Fundus photo:
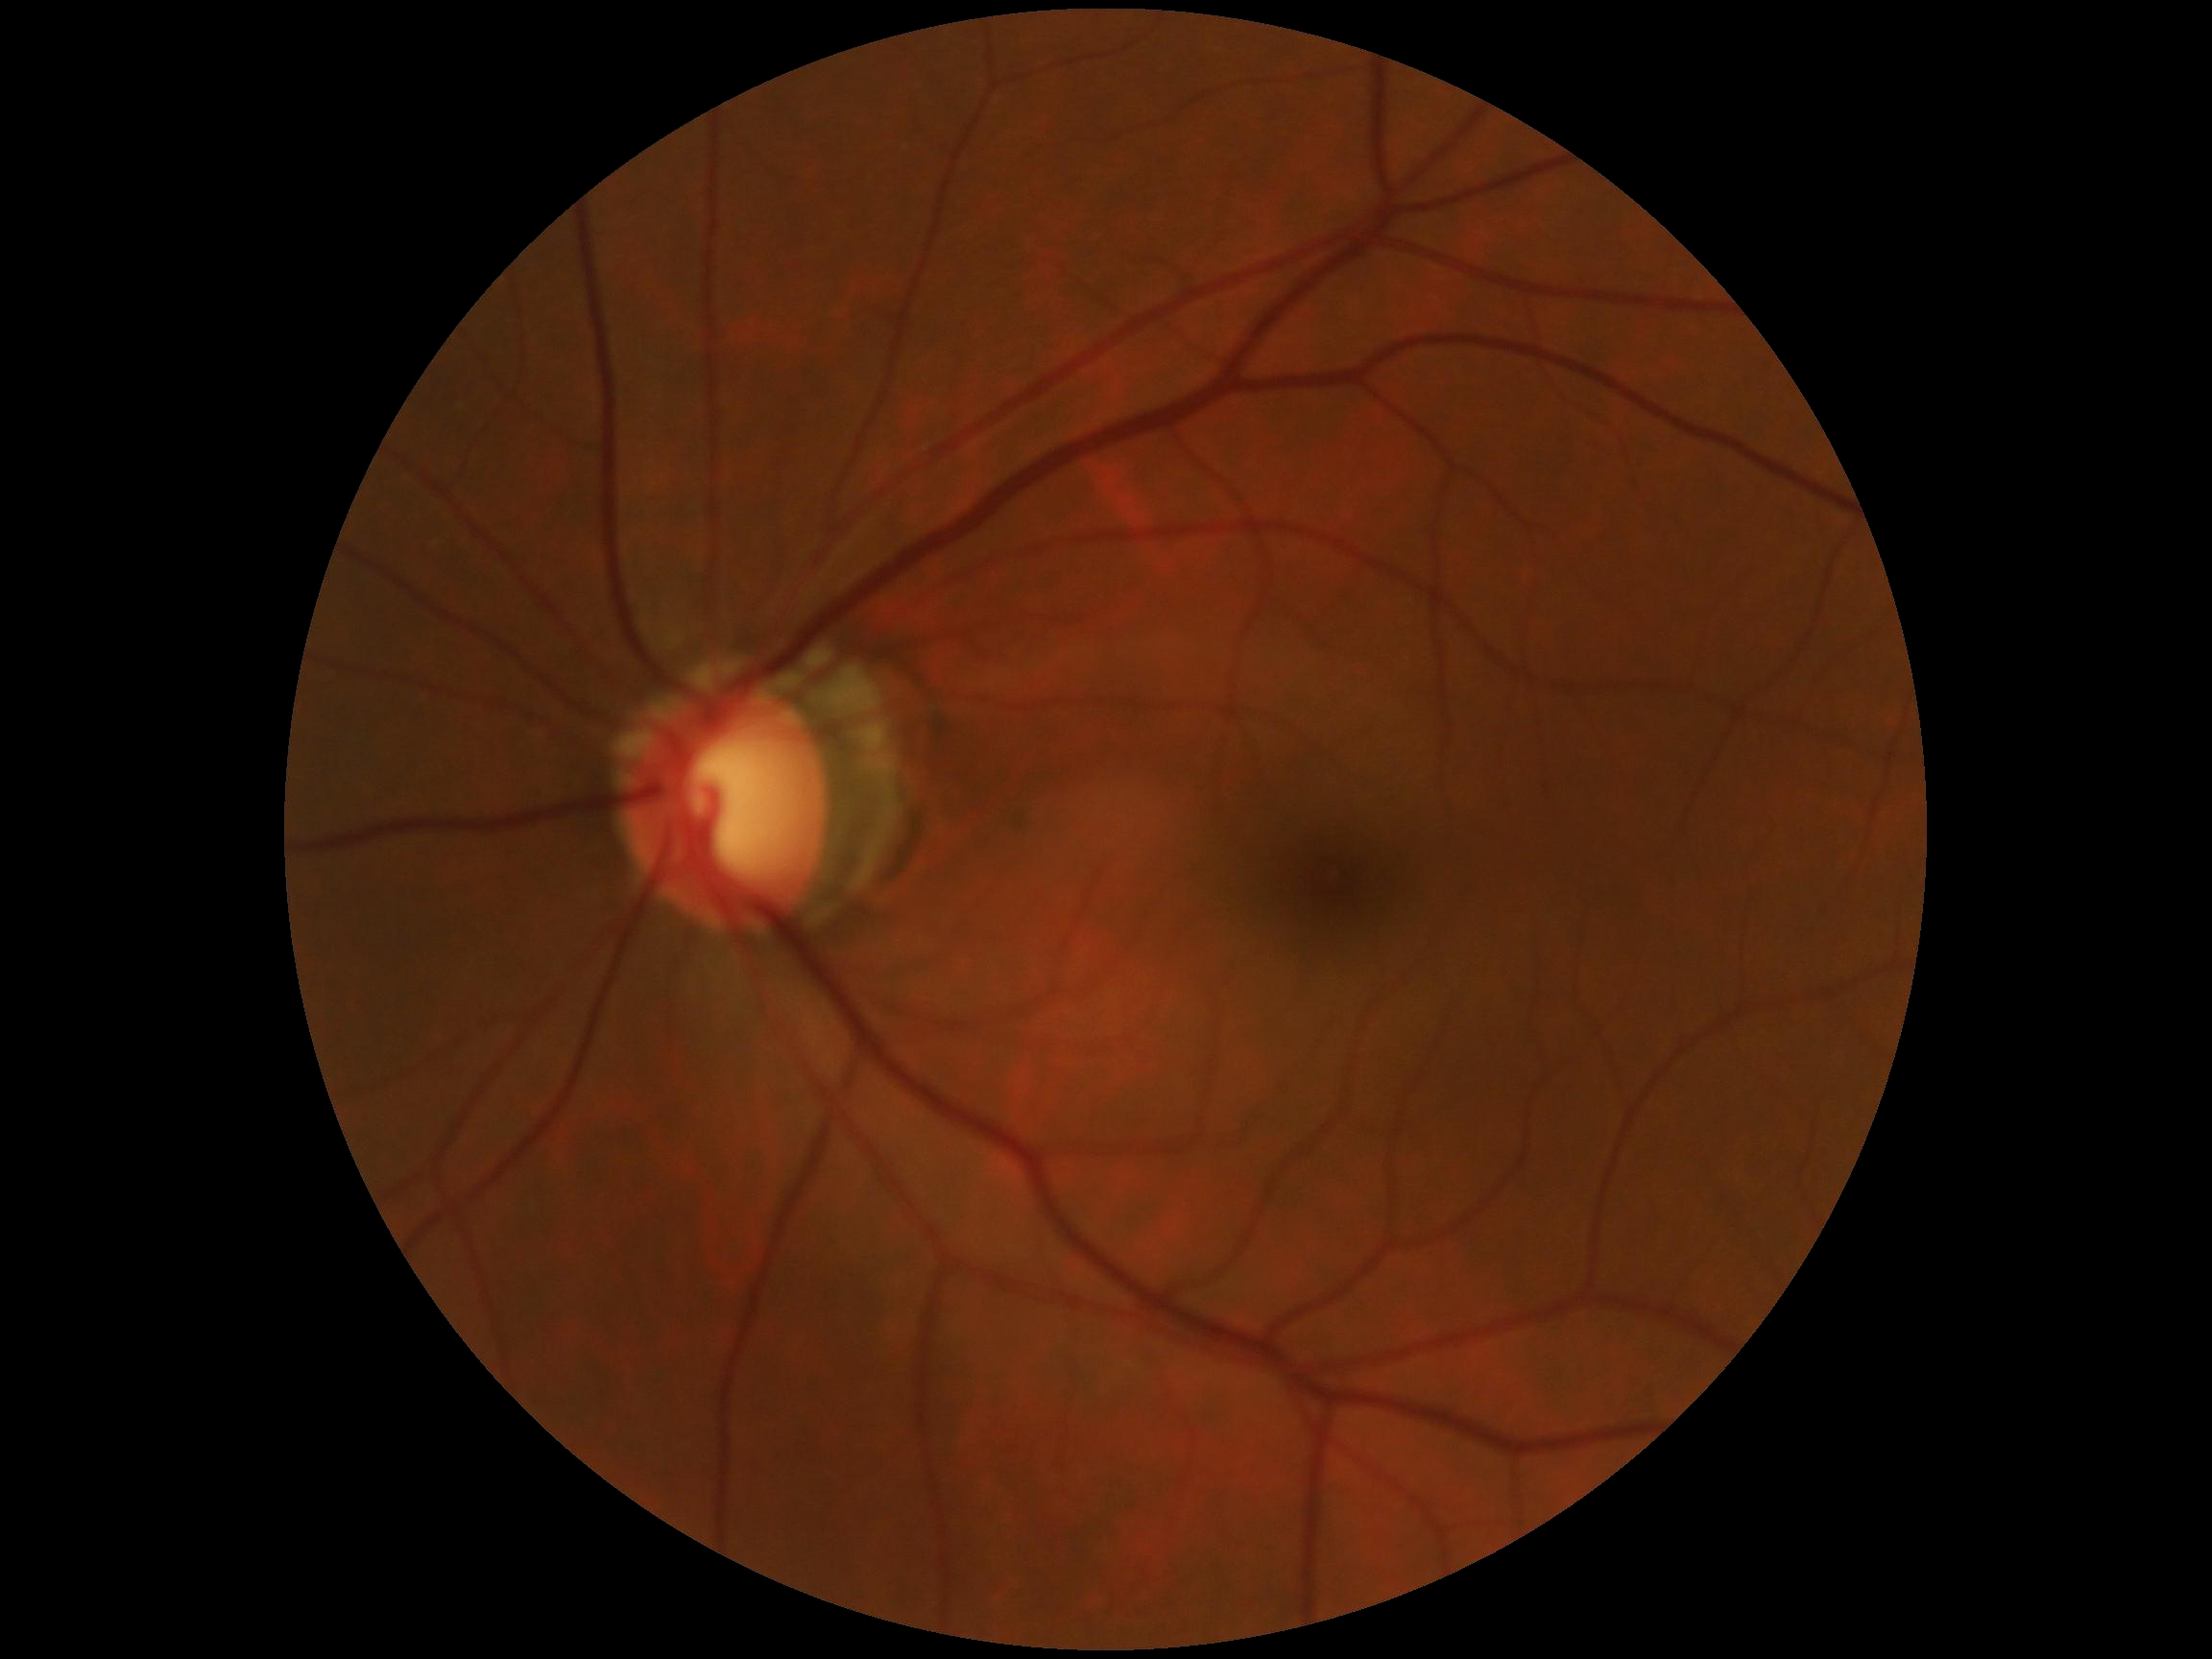

{
  "dr_grade": "0"
}